Color fundus image:
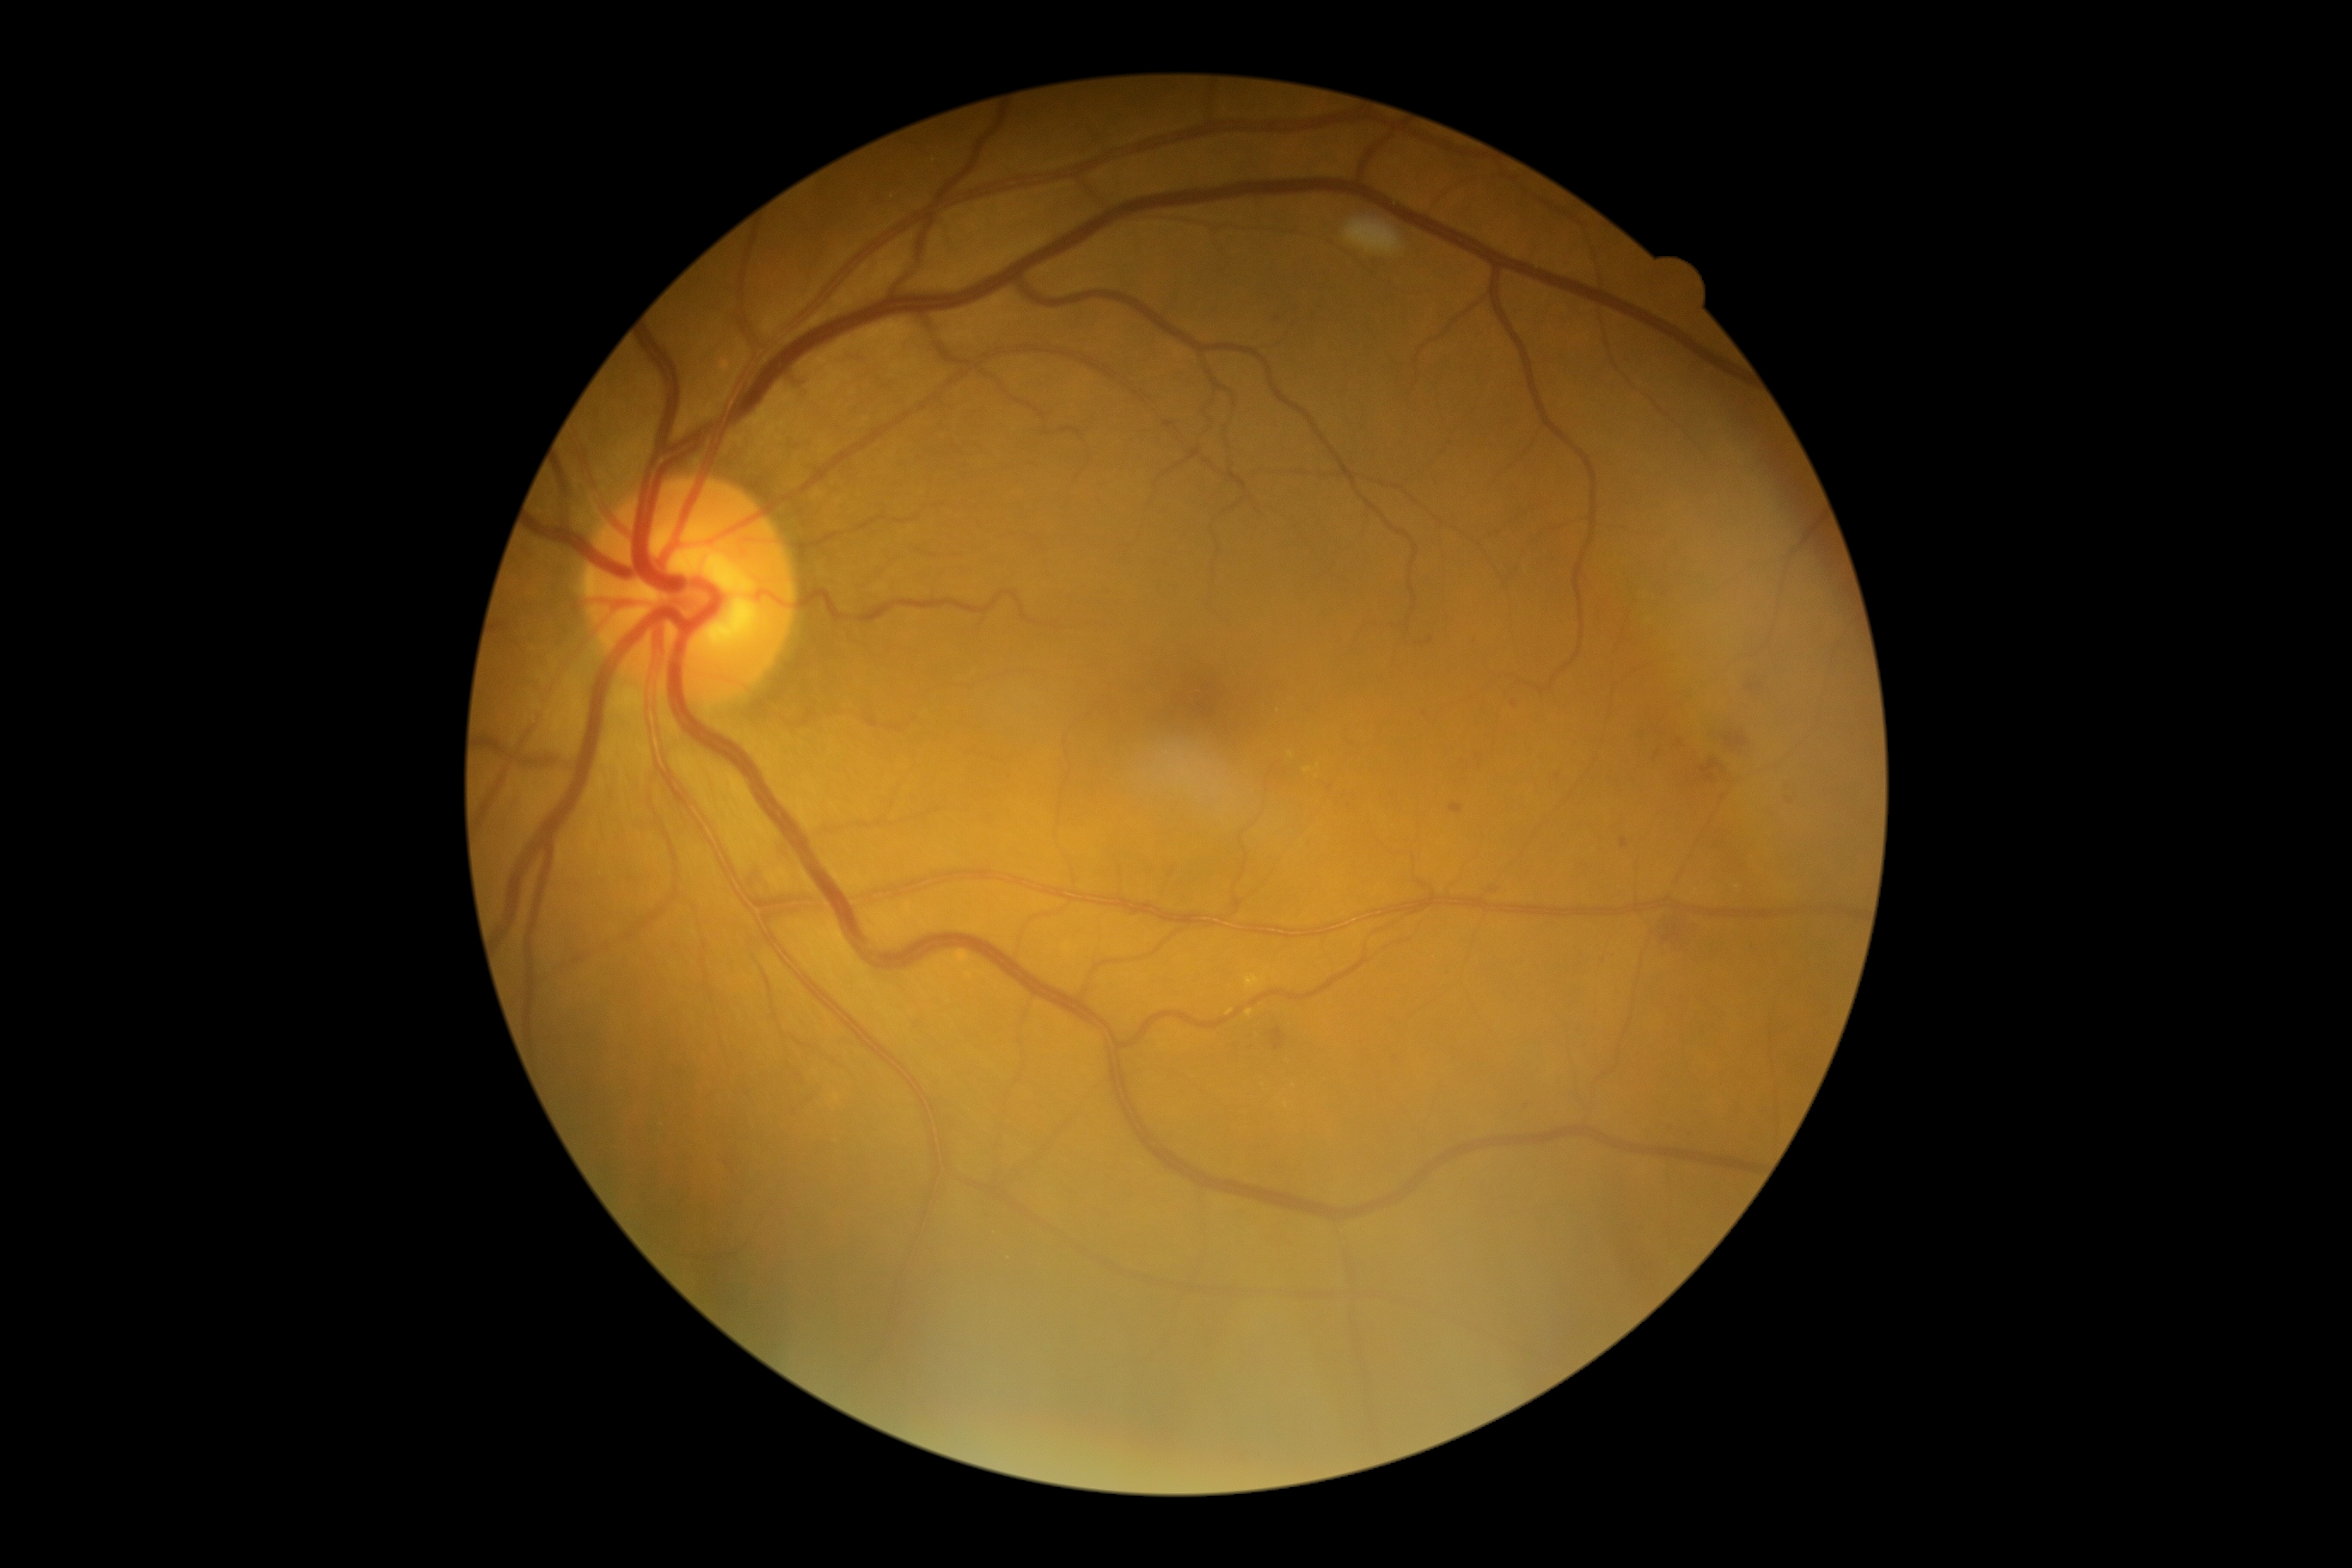

Disease class: non-proliferative diabetic retinopathy.
Retinopathy: moderate NPDR (grade 2).